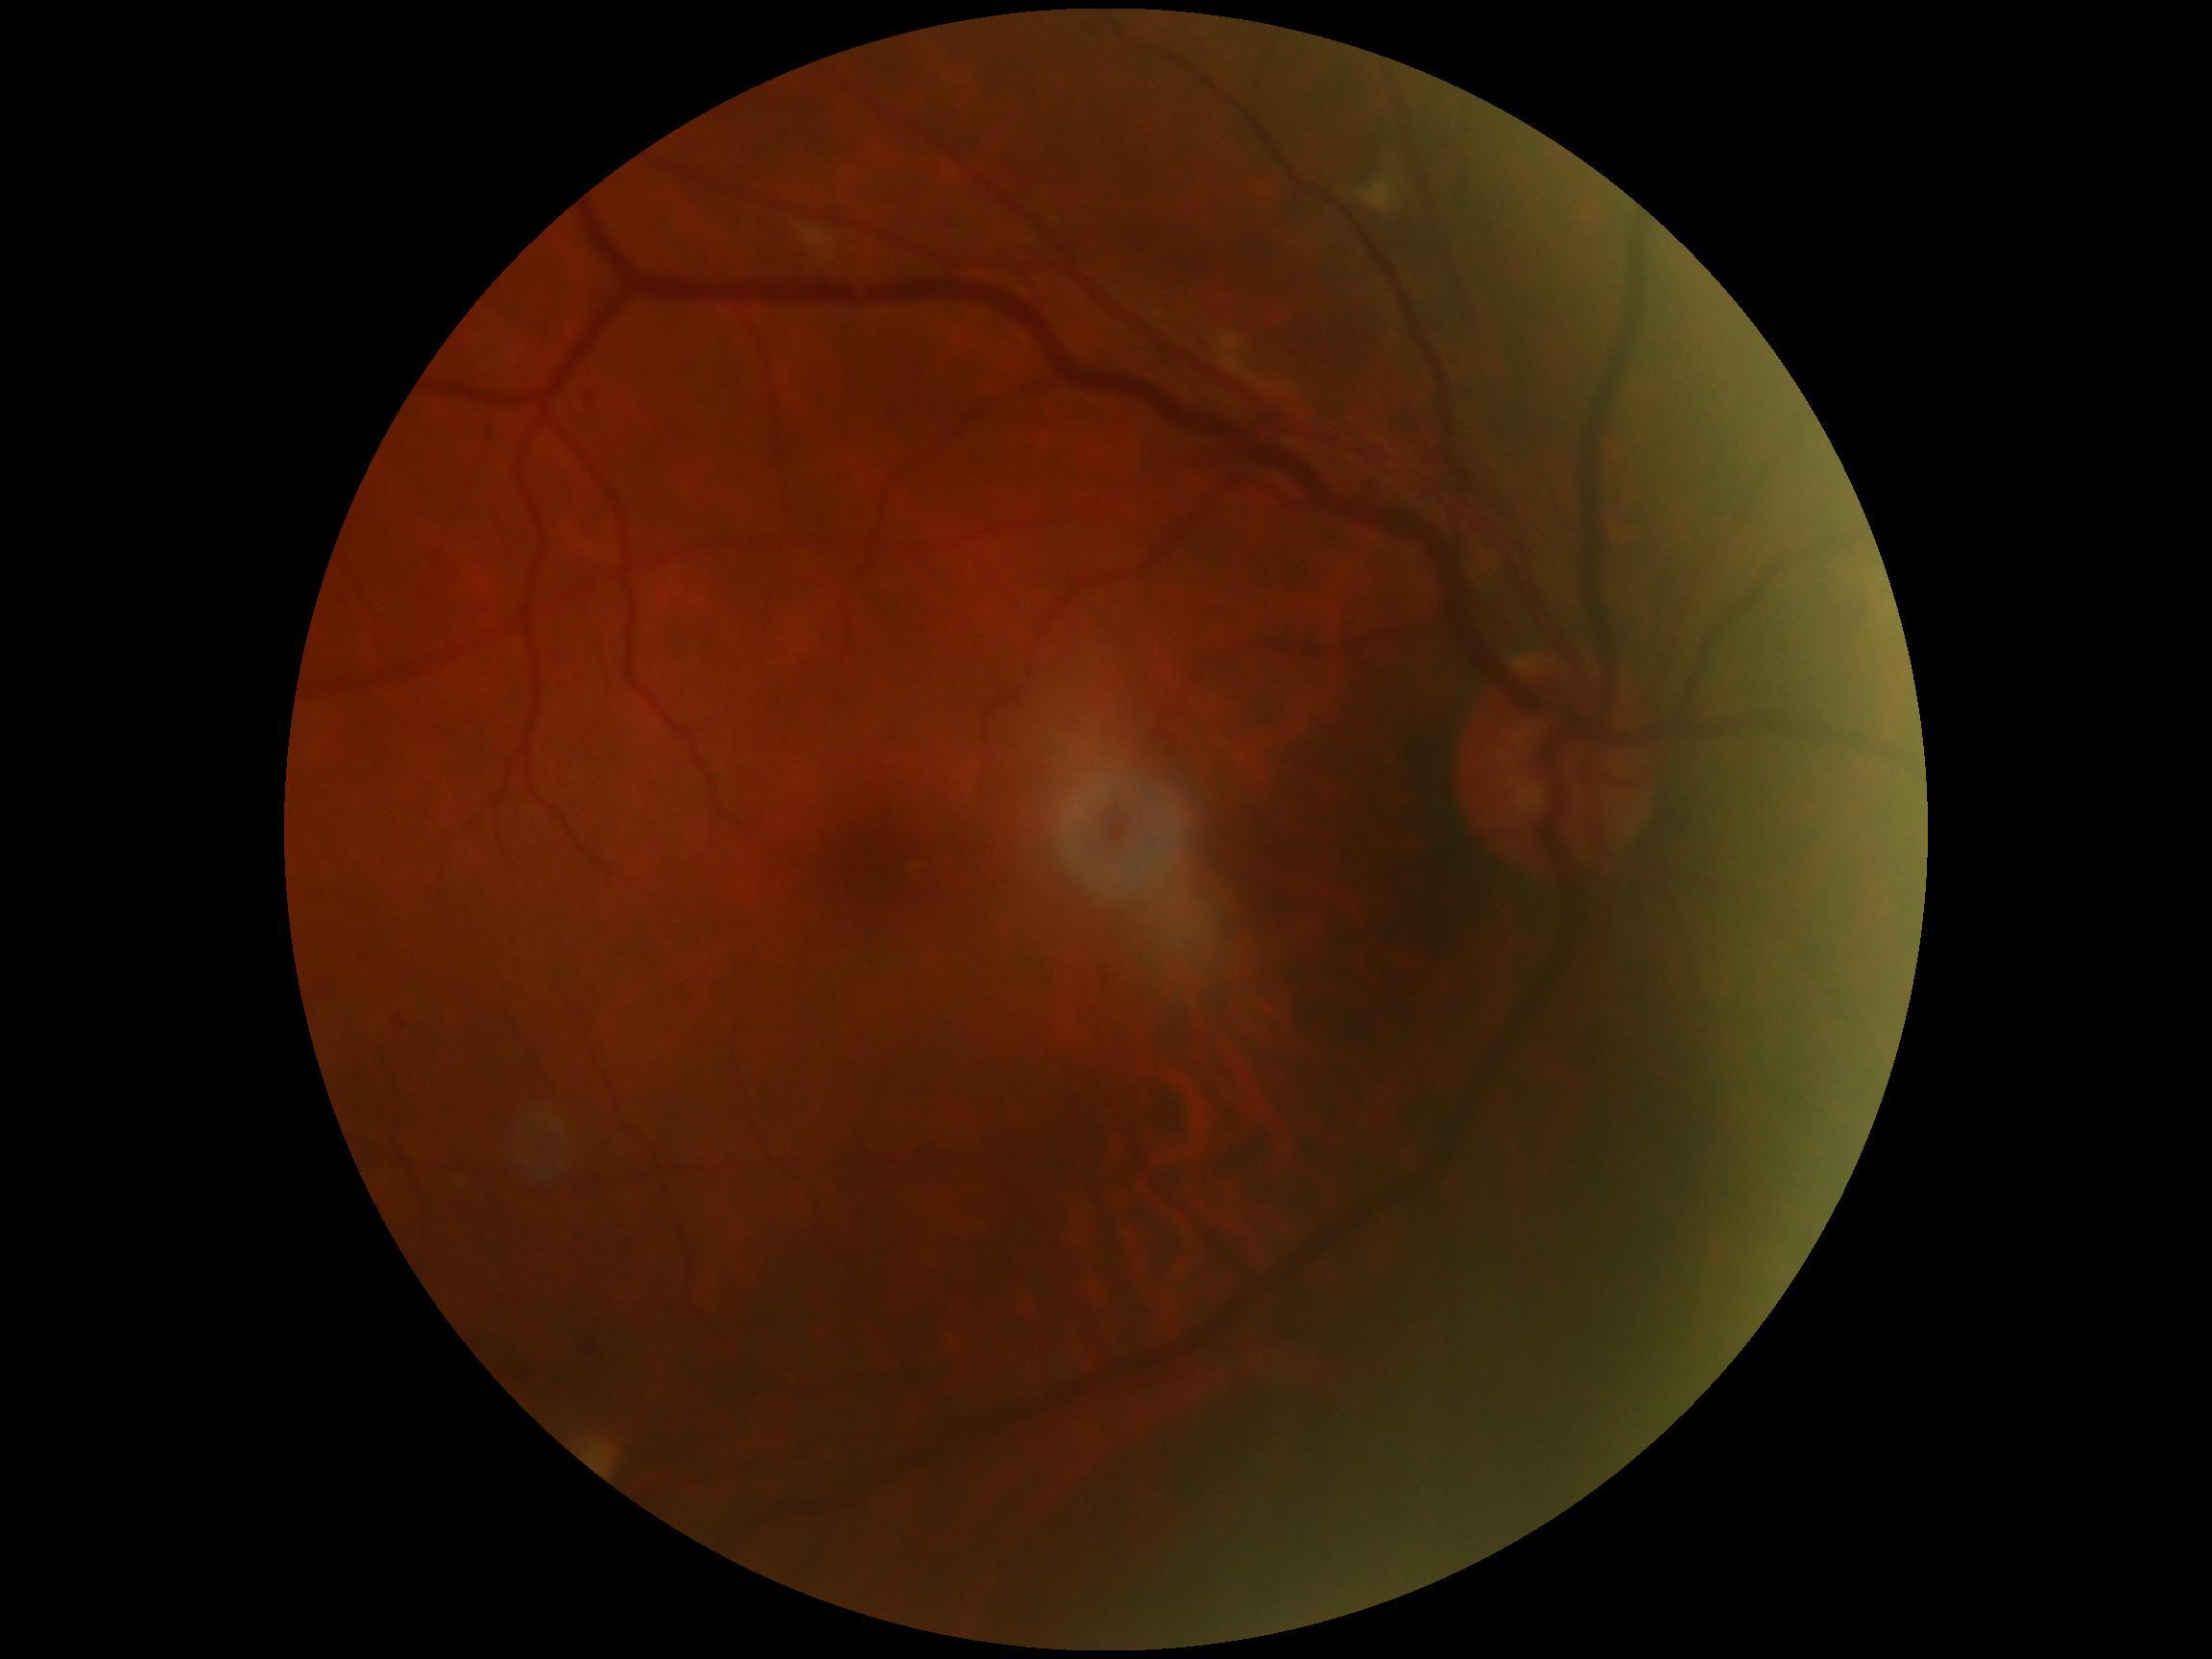
Diabetic retinopathy (DR) is grade 2 (moderate NPDR) — more than just microaneurysms but less than severe NPDR.